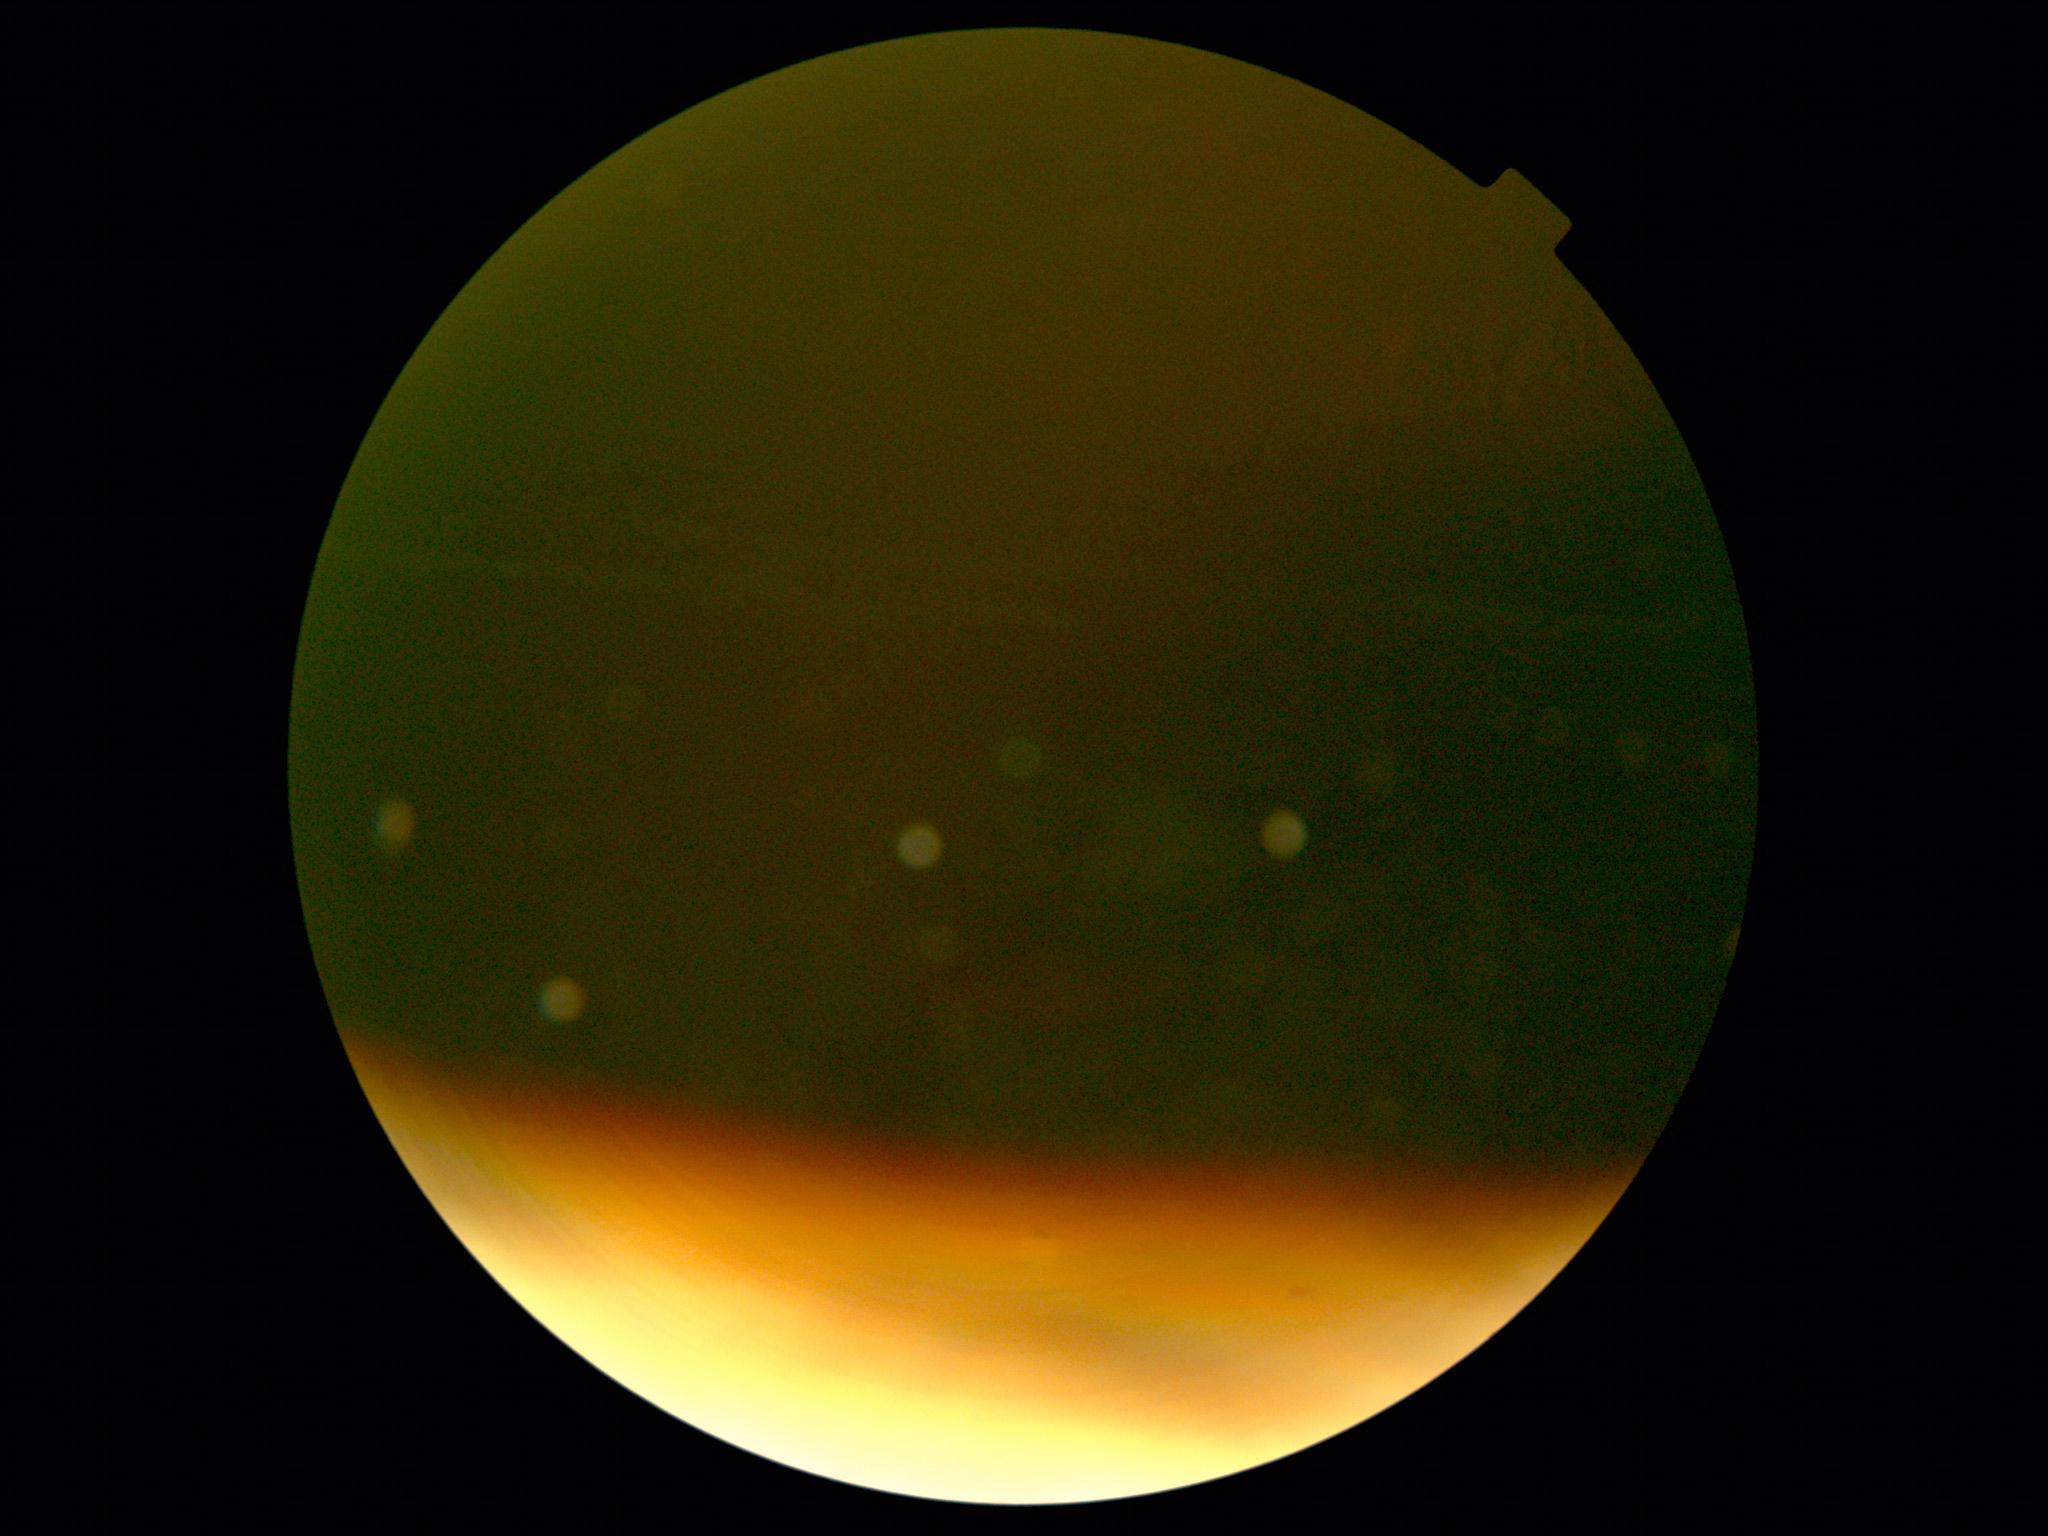

image quality: below grading threshold; retinopathy grade: ungradable due to poor image quality.